50° field of view · color fundus photograph
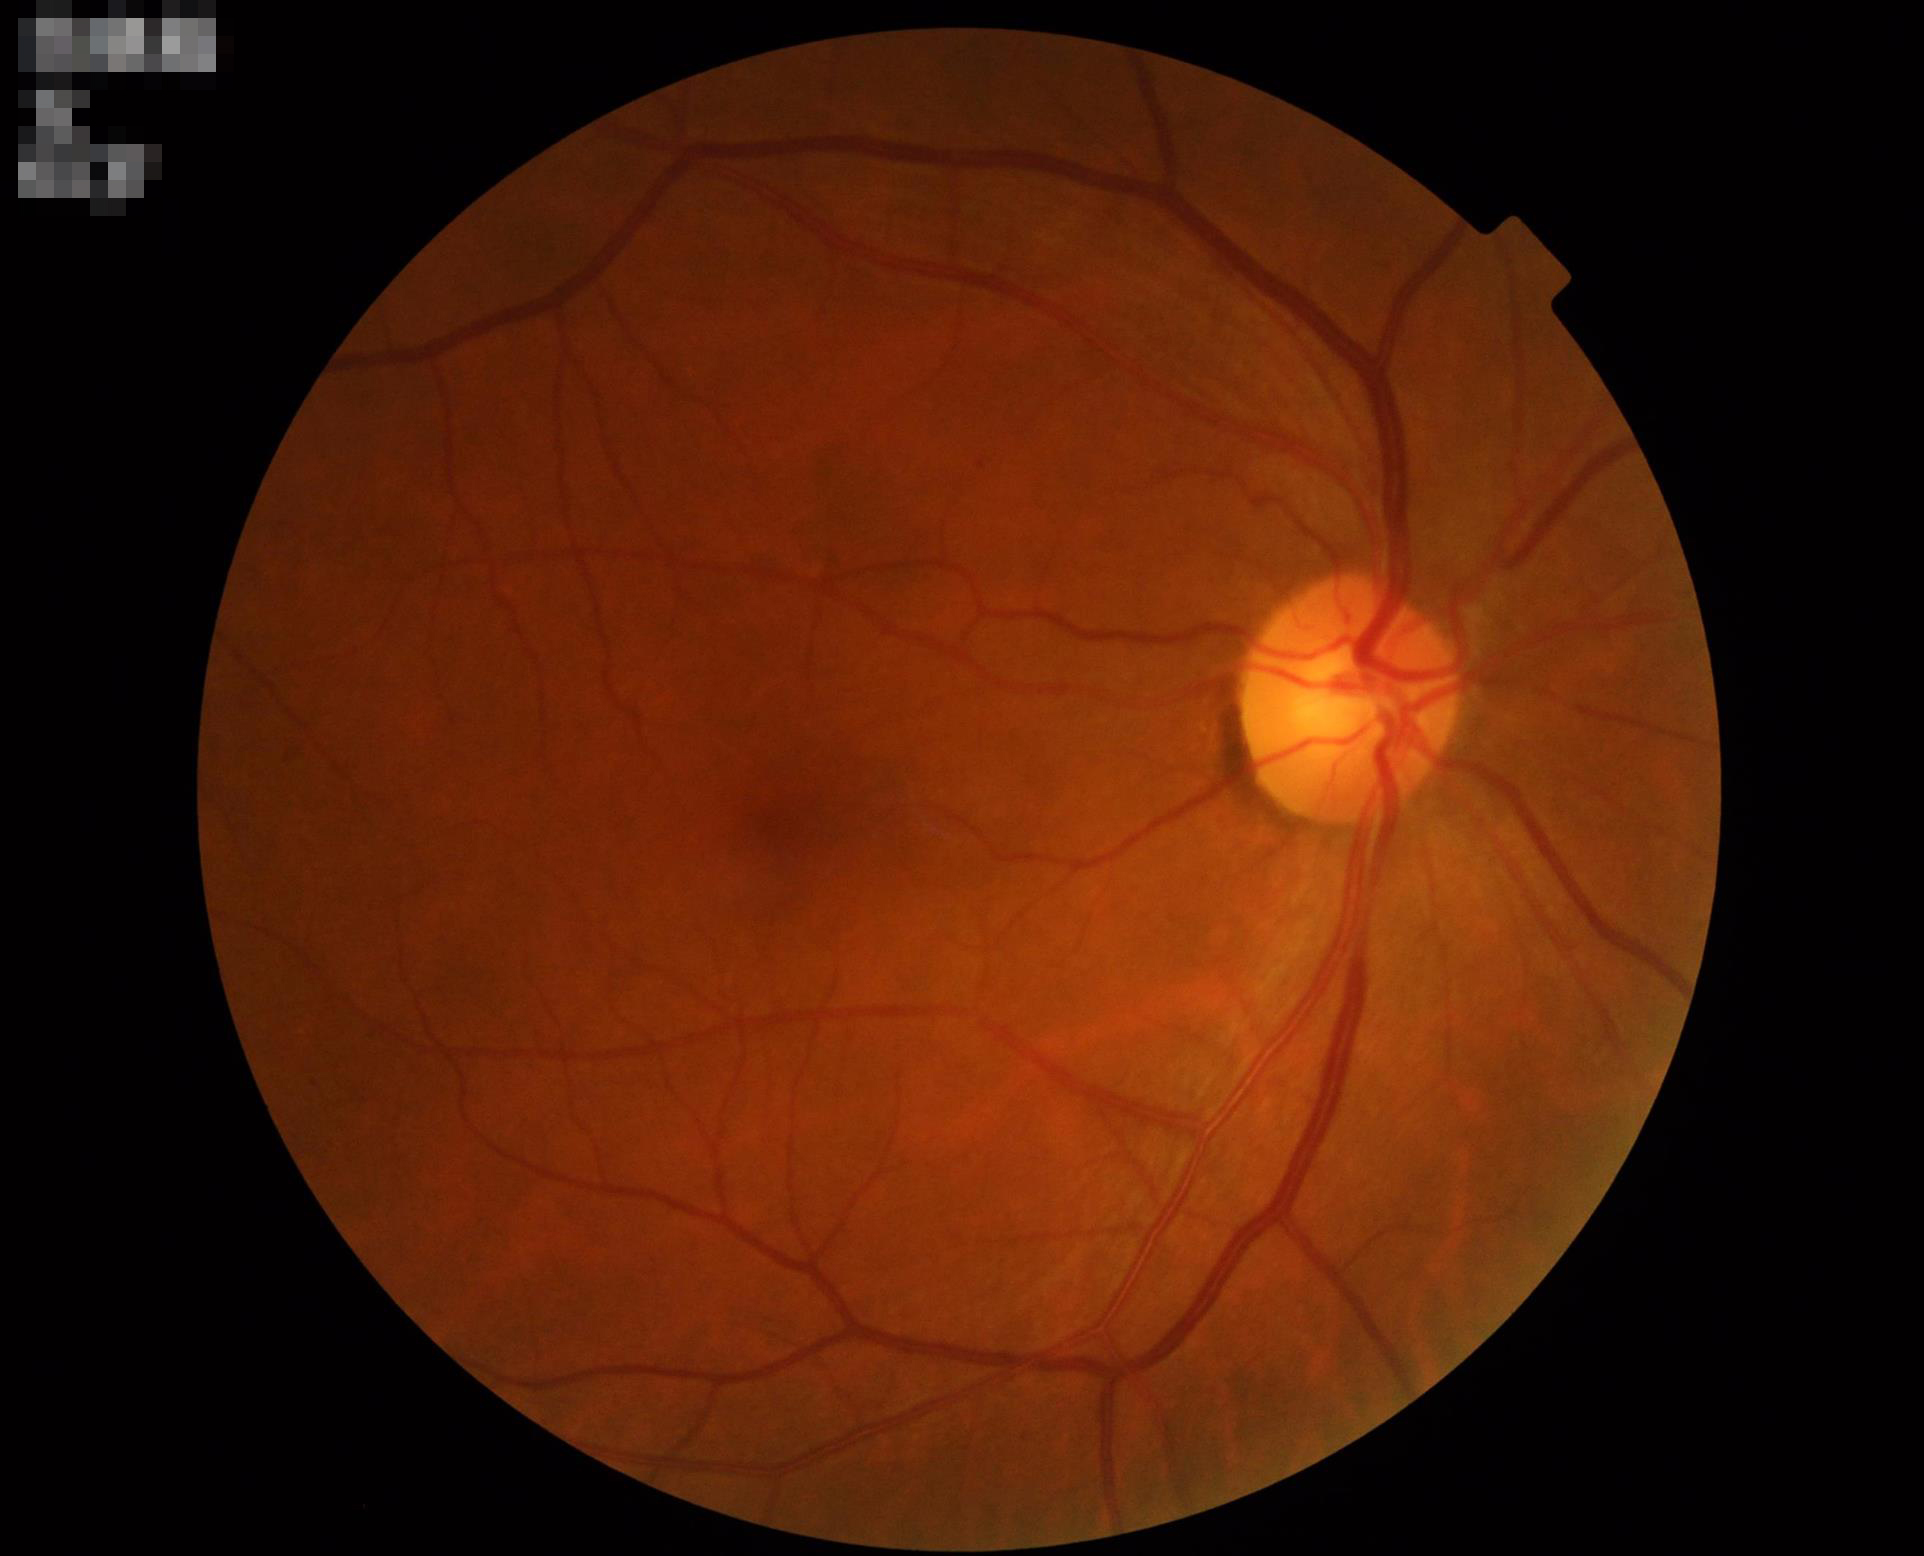 Illumination = satisfactory; Focus = sharp; Contrast = good; Overall quality = acceptable.